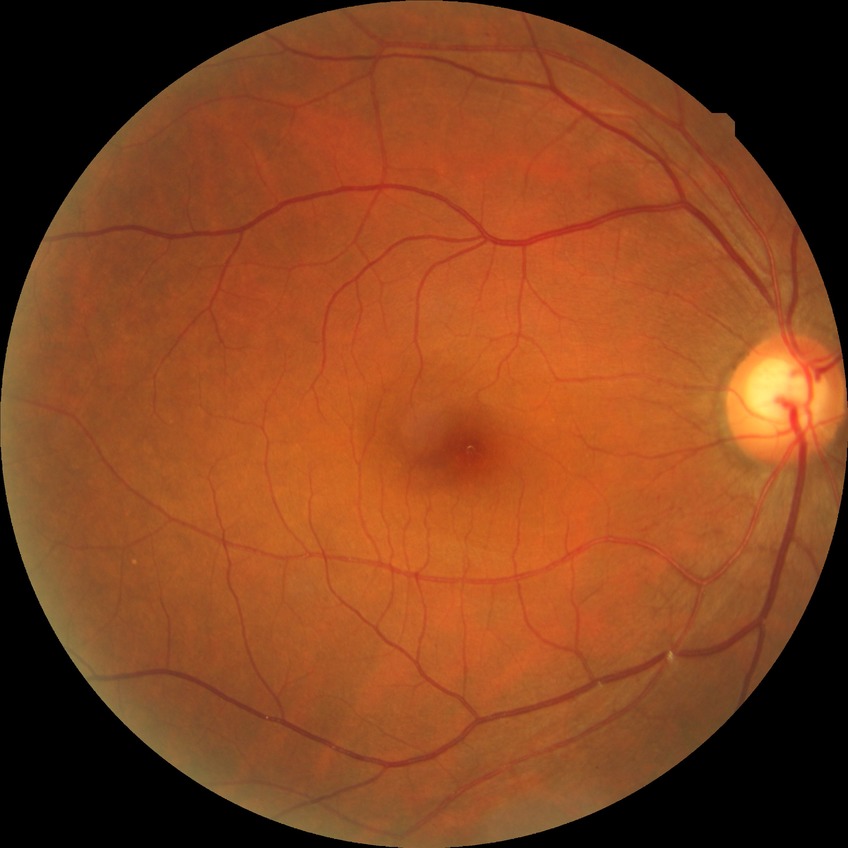 Assessment:
– diabetic retinopathy (DR) — no diabetic retinopathy (NDR)